45 degree fundus photograph, camera: NIDEK AFC-230, nonmydriatic, modified Davis classification:
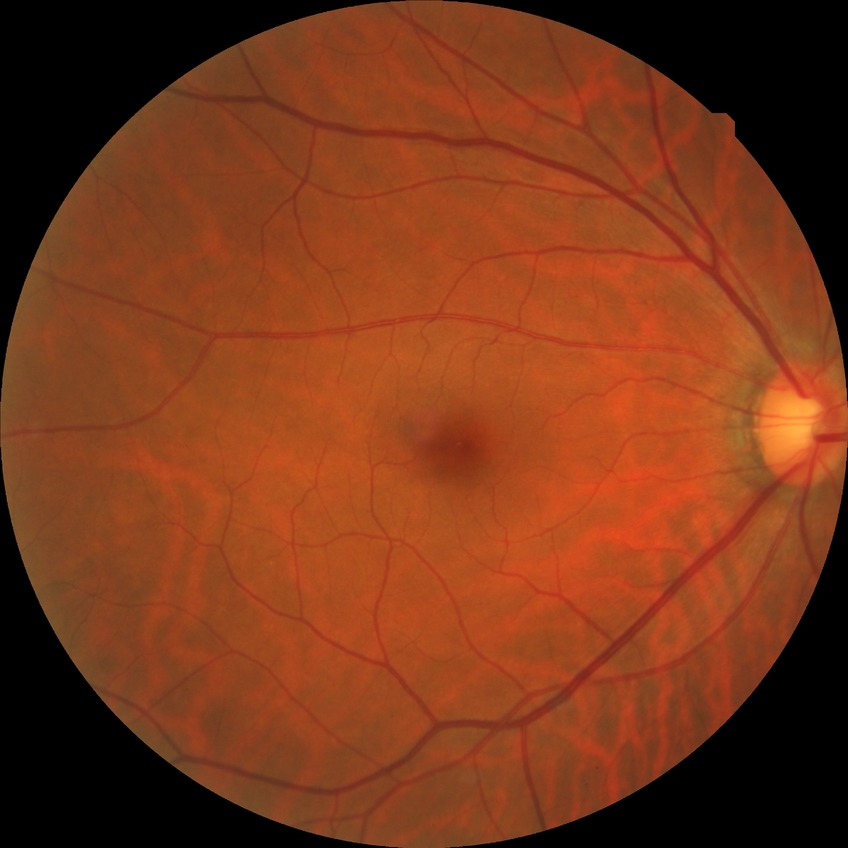

DR: NDR